1440x1080px. Pediatric retinal photograph (wide-field):
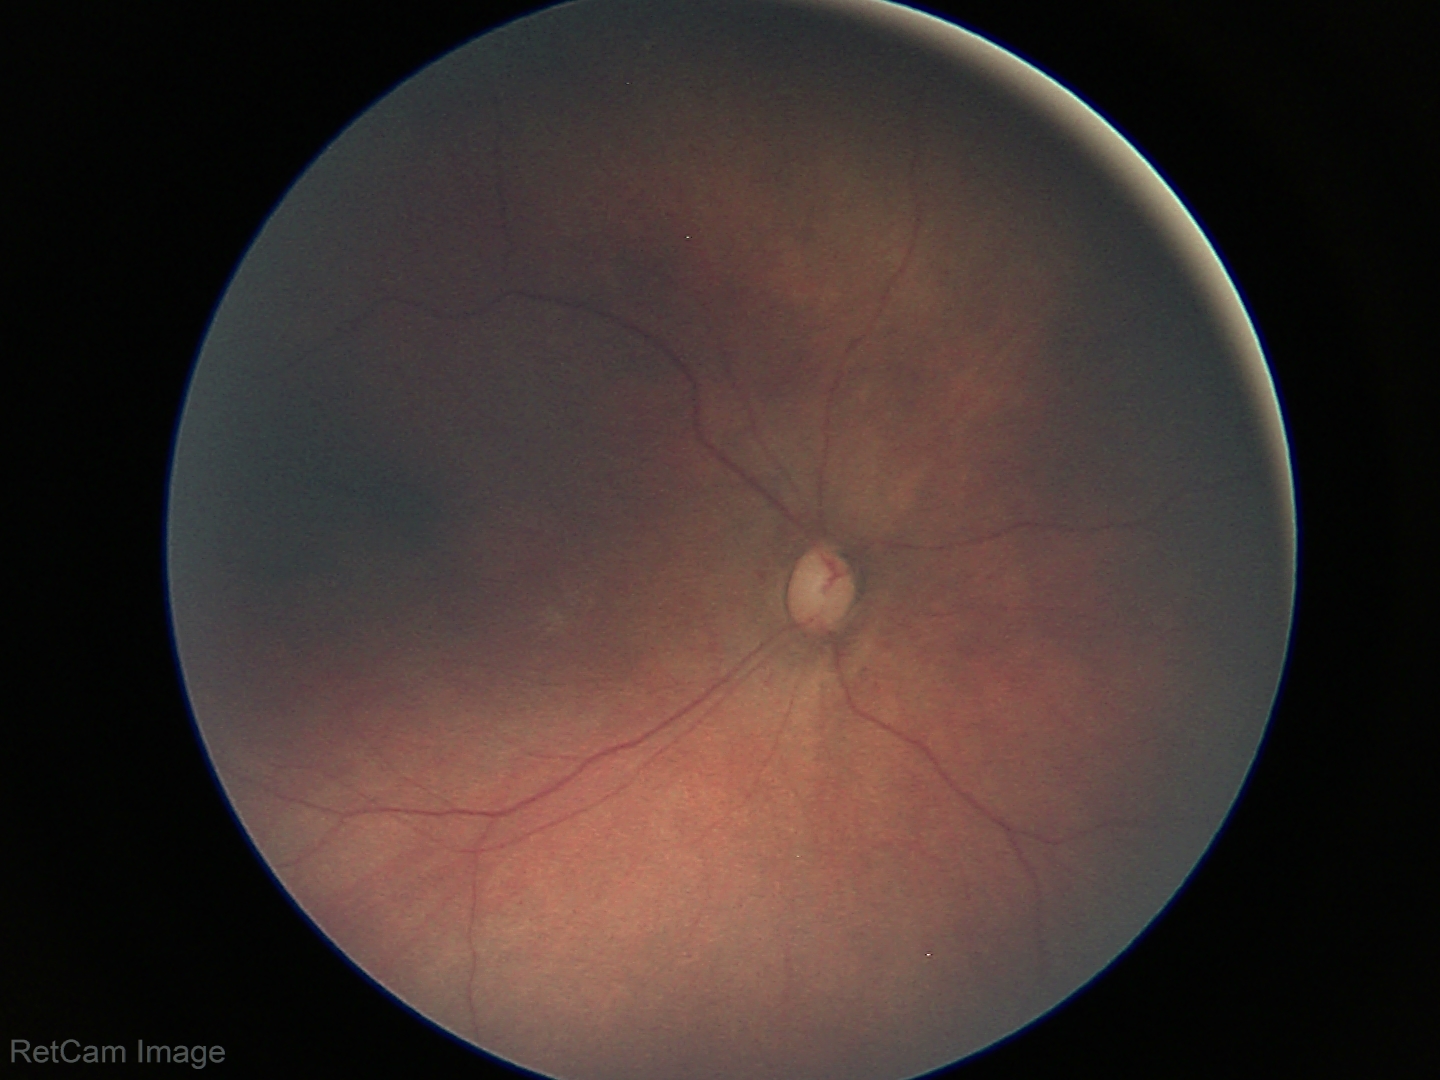
Normal screening examination.